Fundus photo.
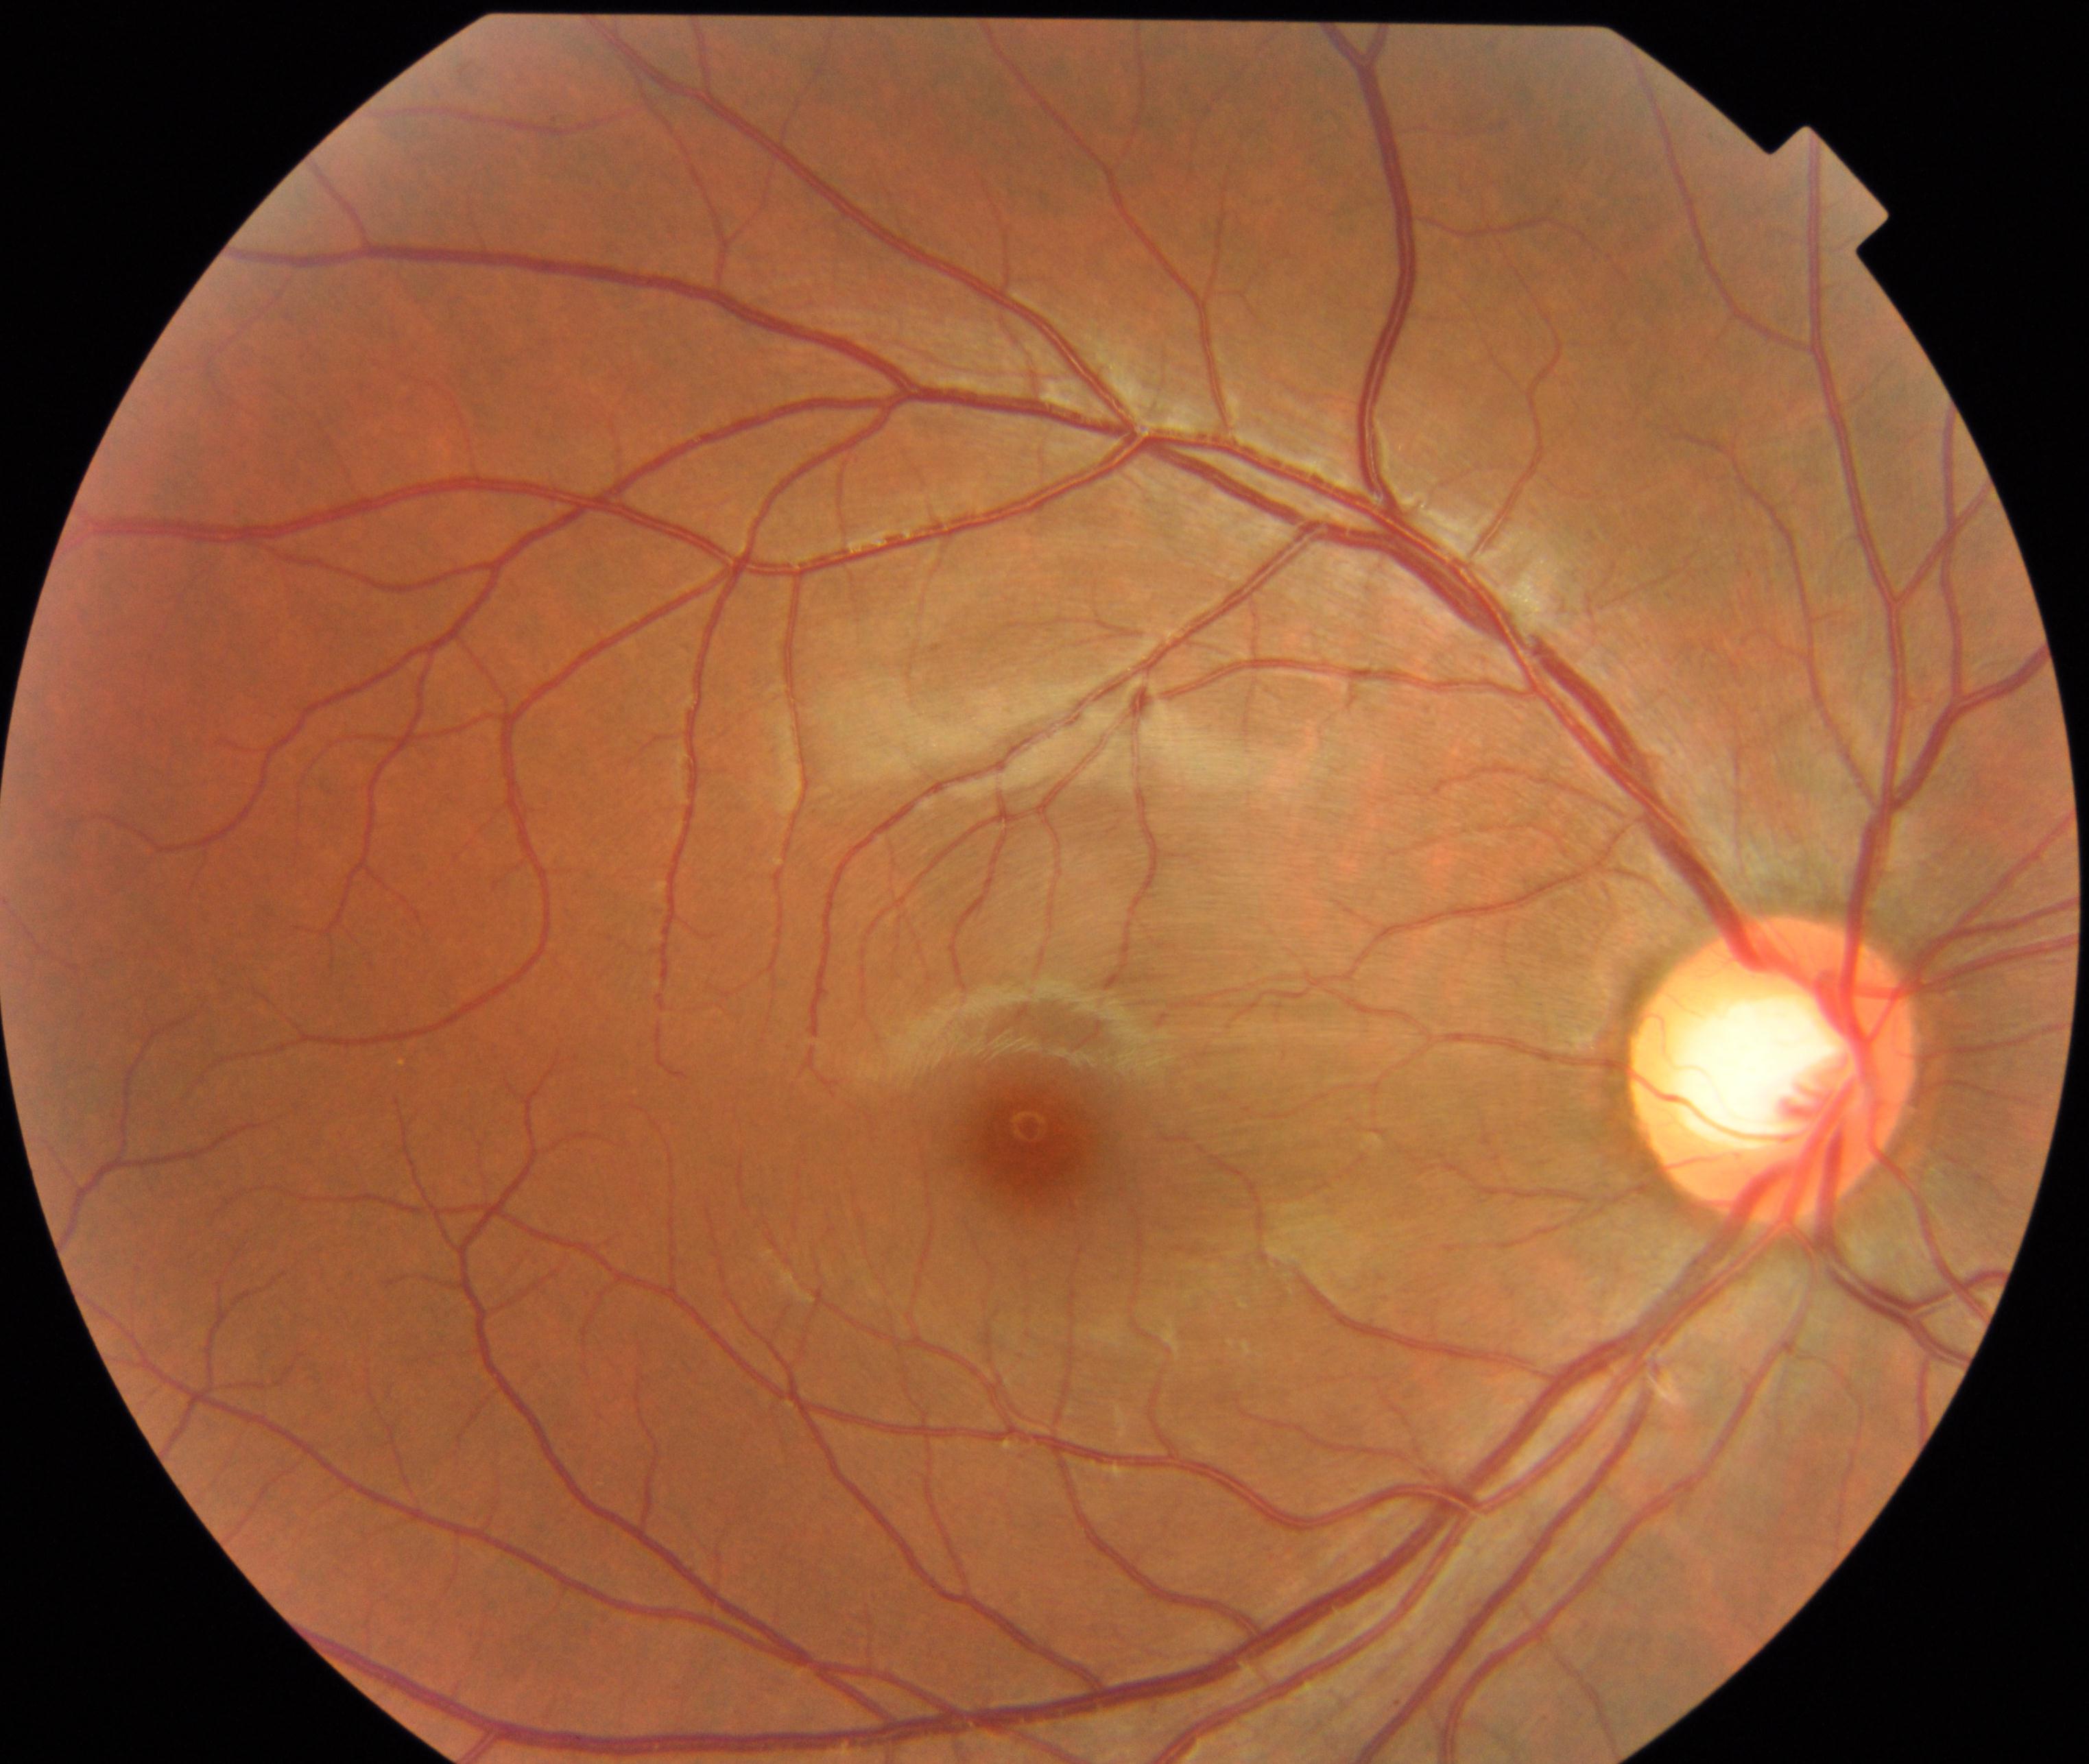 The image shows large optic cup.